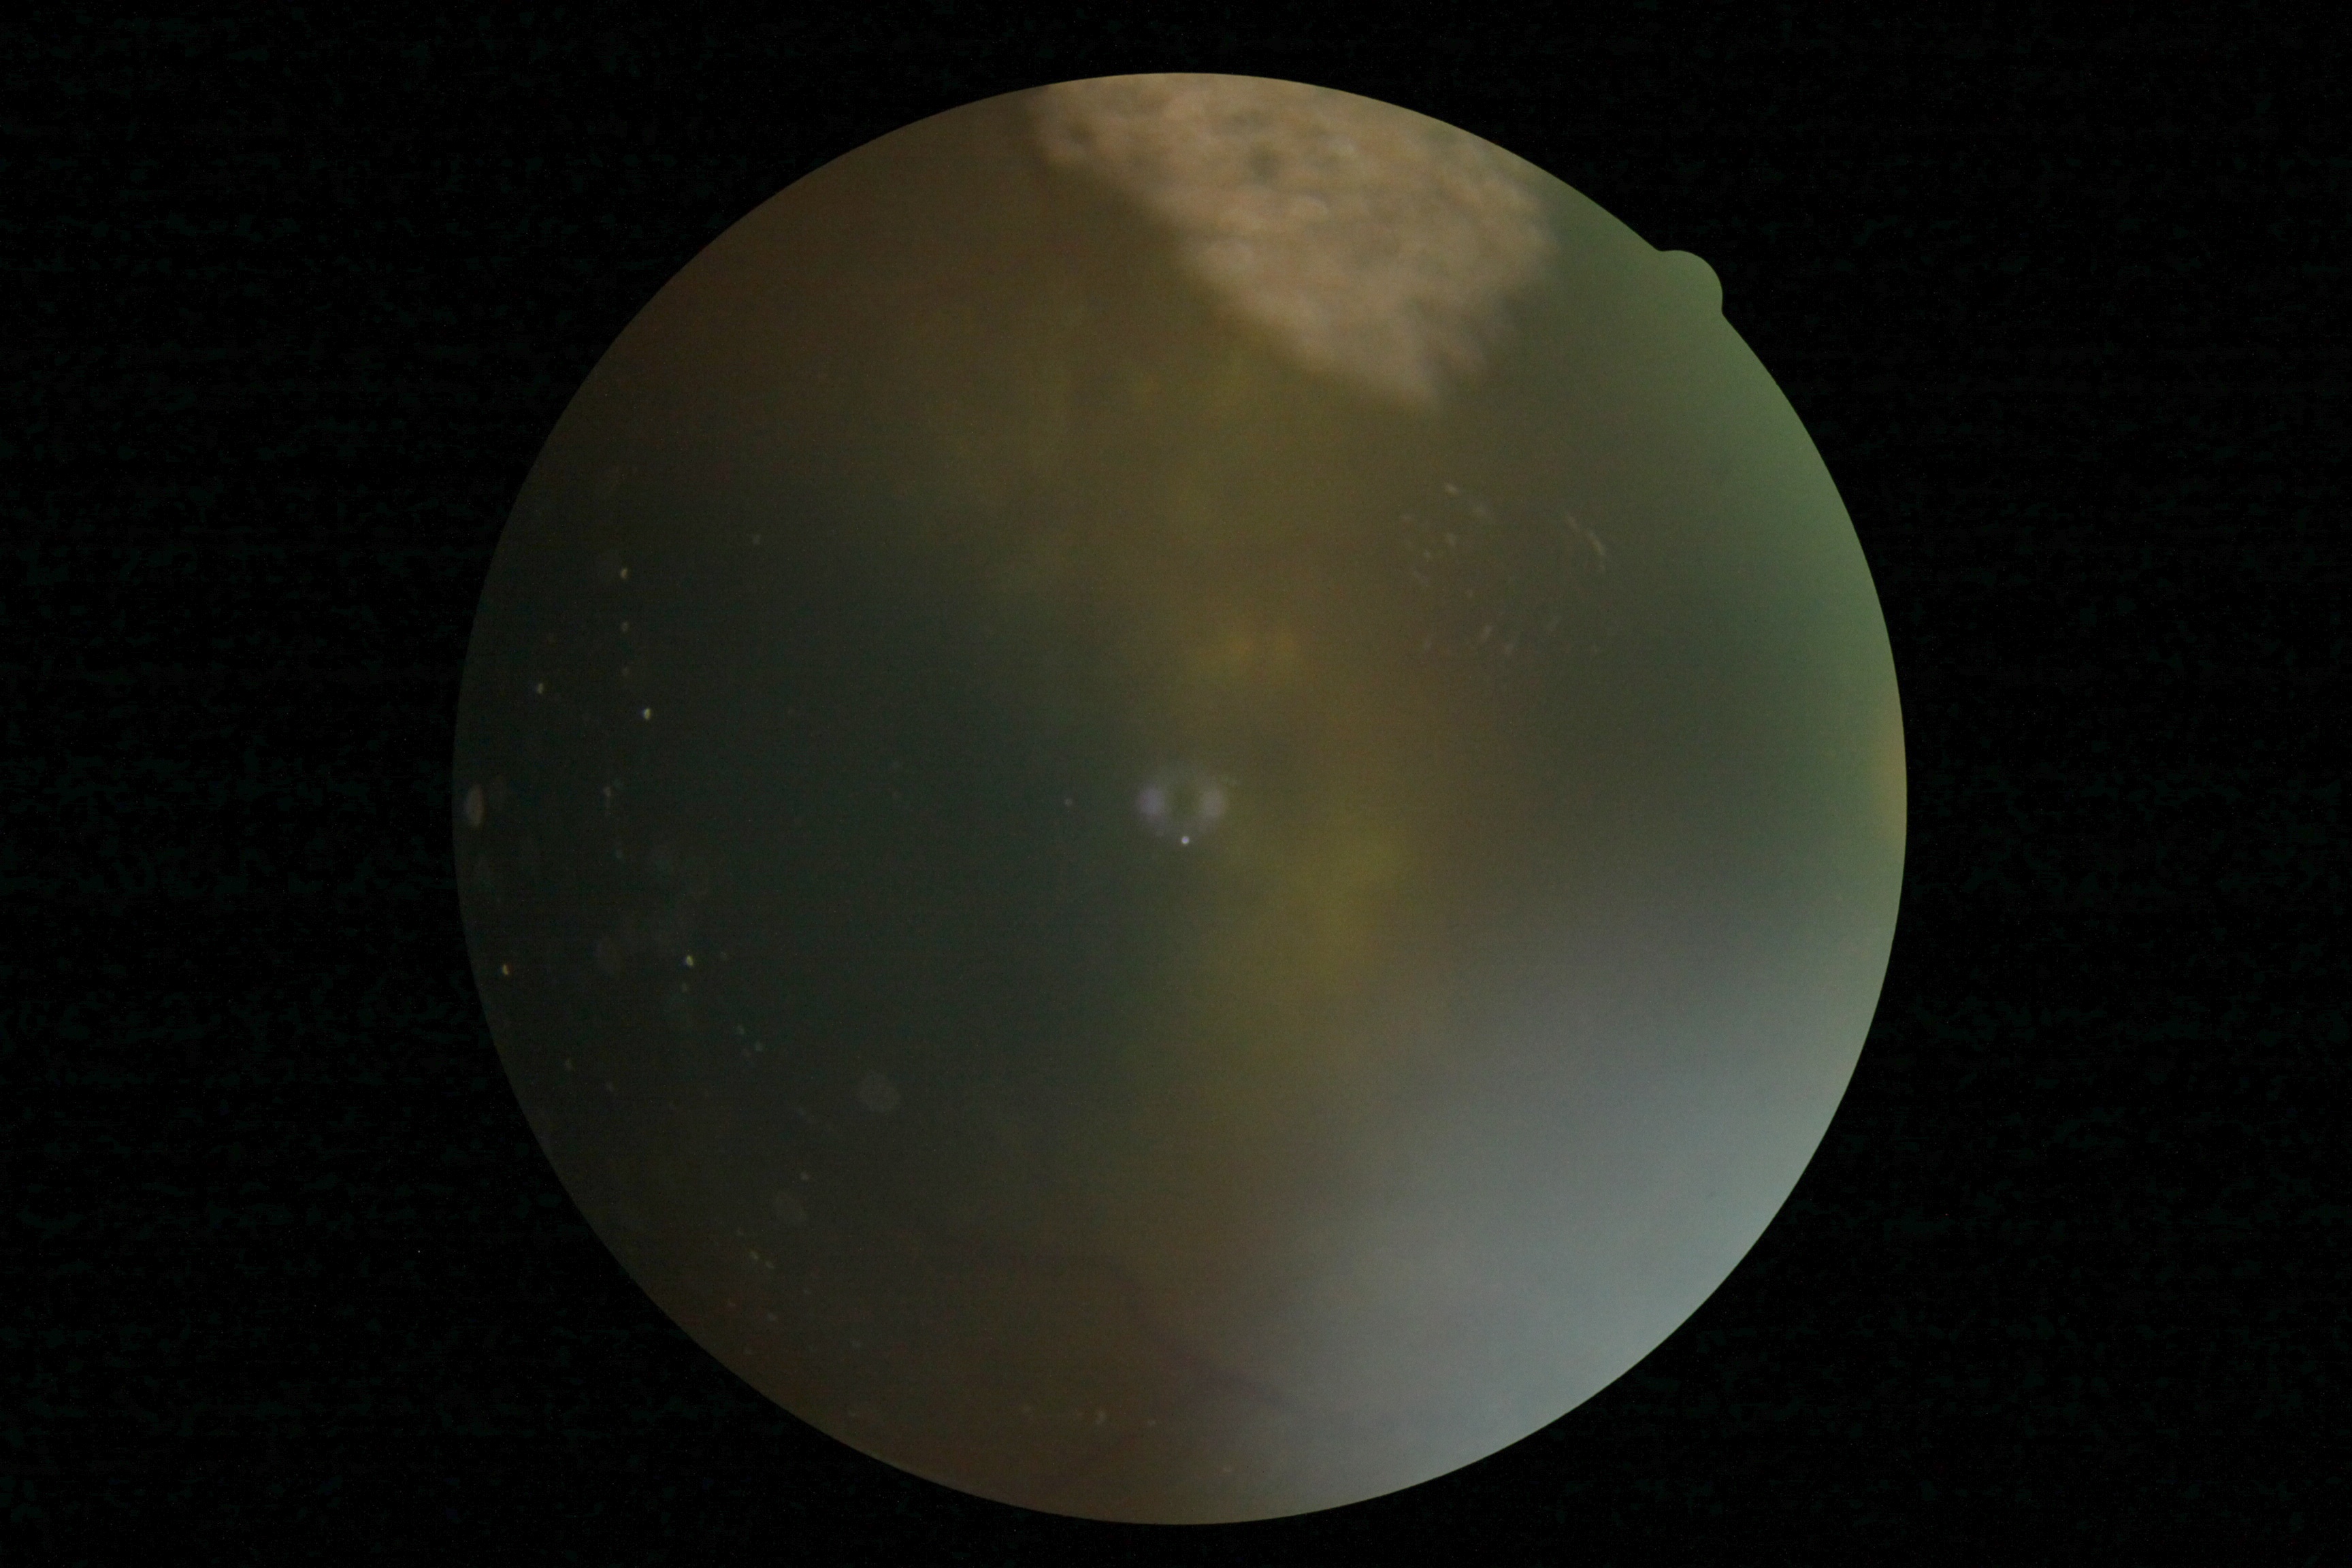
DR severity is ungradable.